DR severity per modified Davis staging, NIDEK AFC-230 fundus camera — 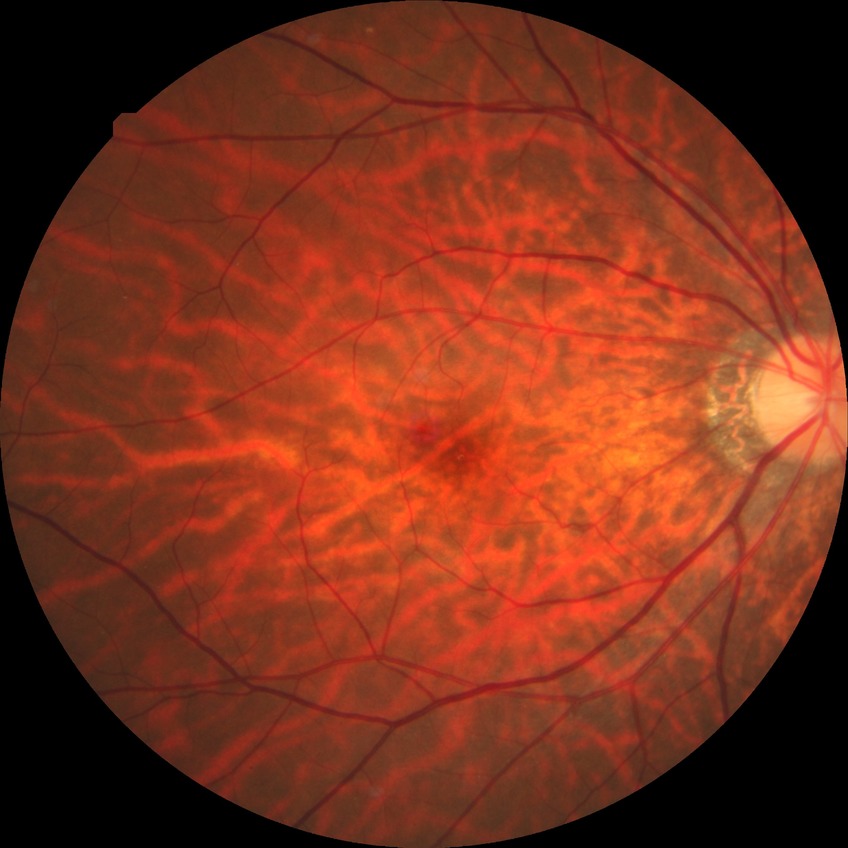

Diabetic retinopathy (DR): no diabetic retinopathy (NDR).